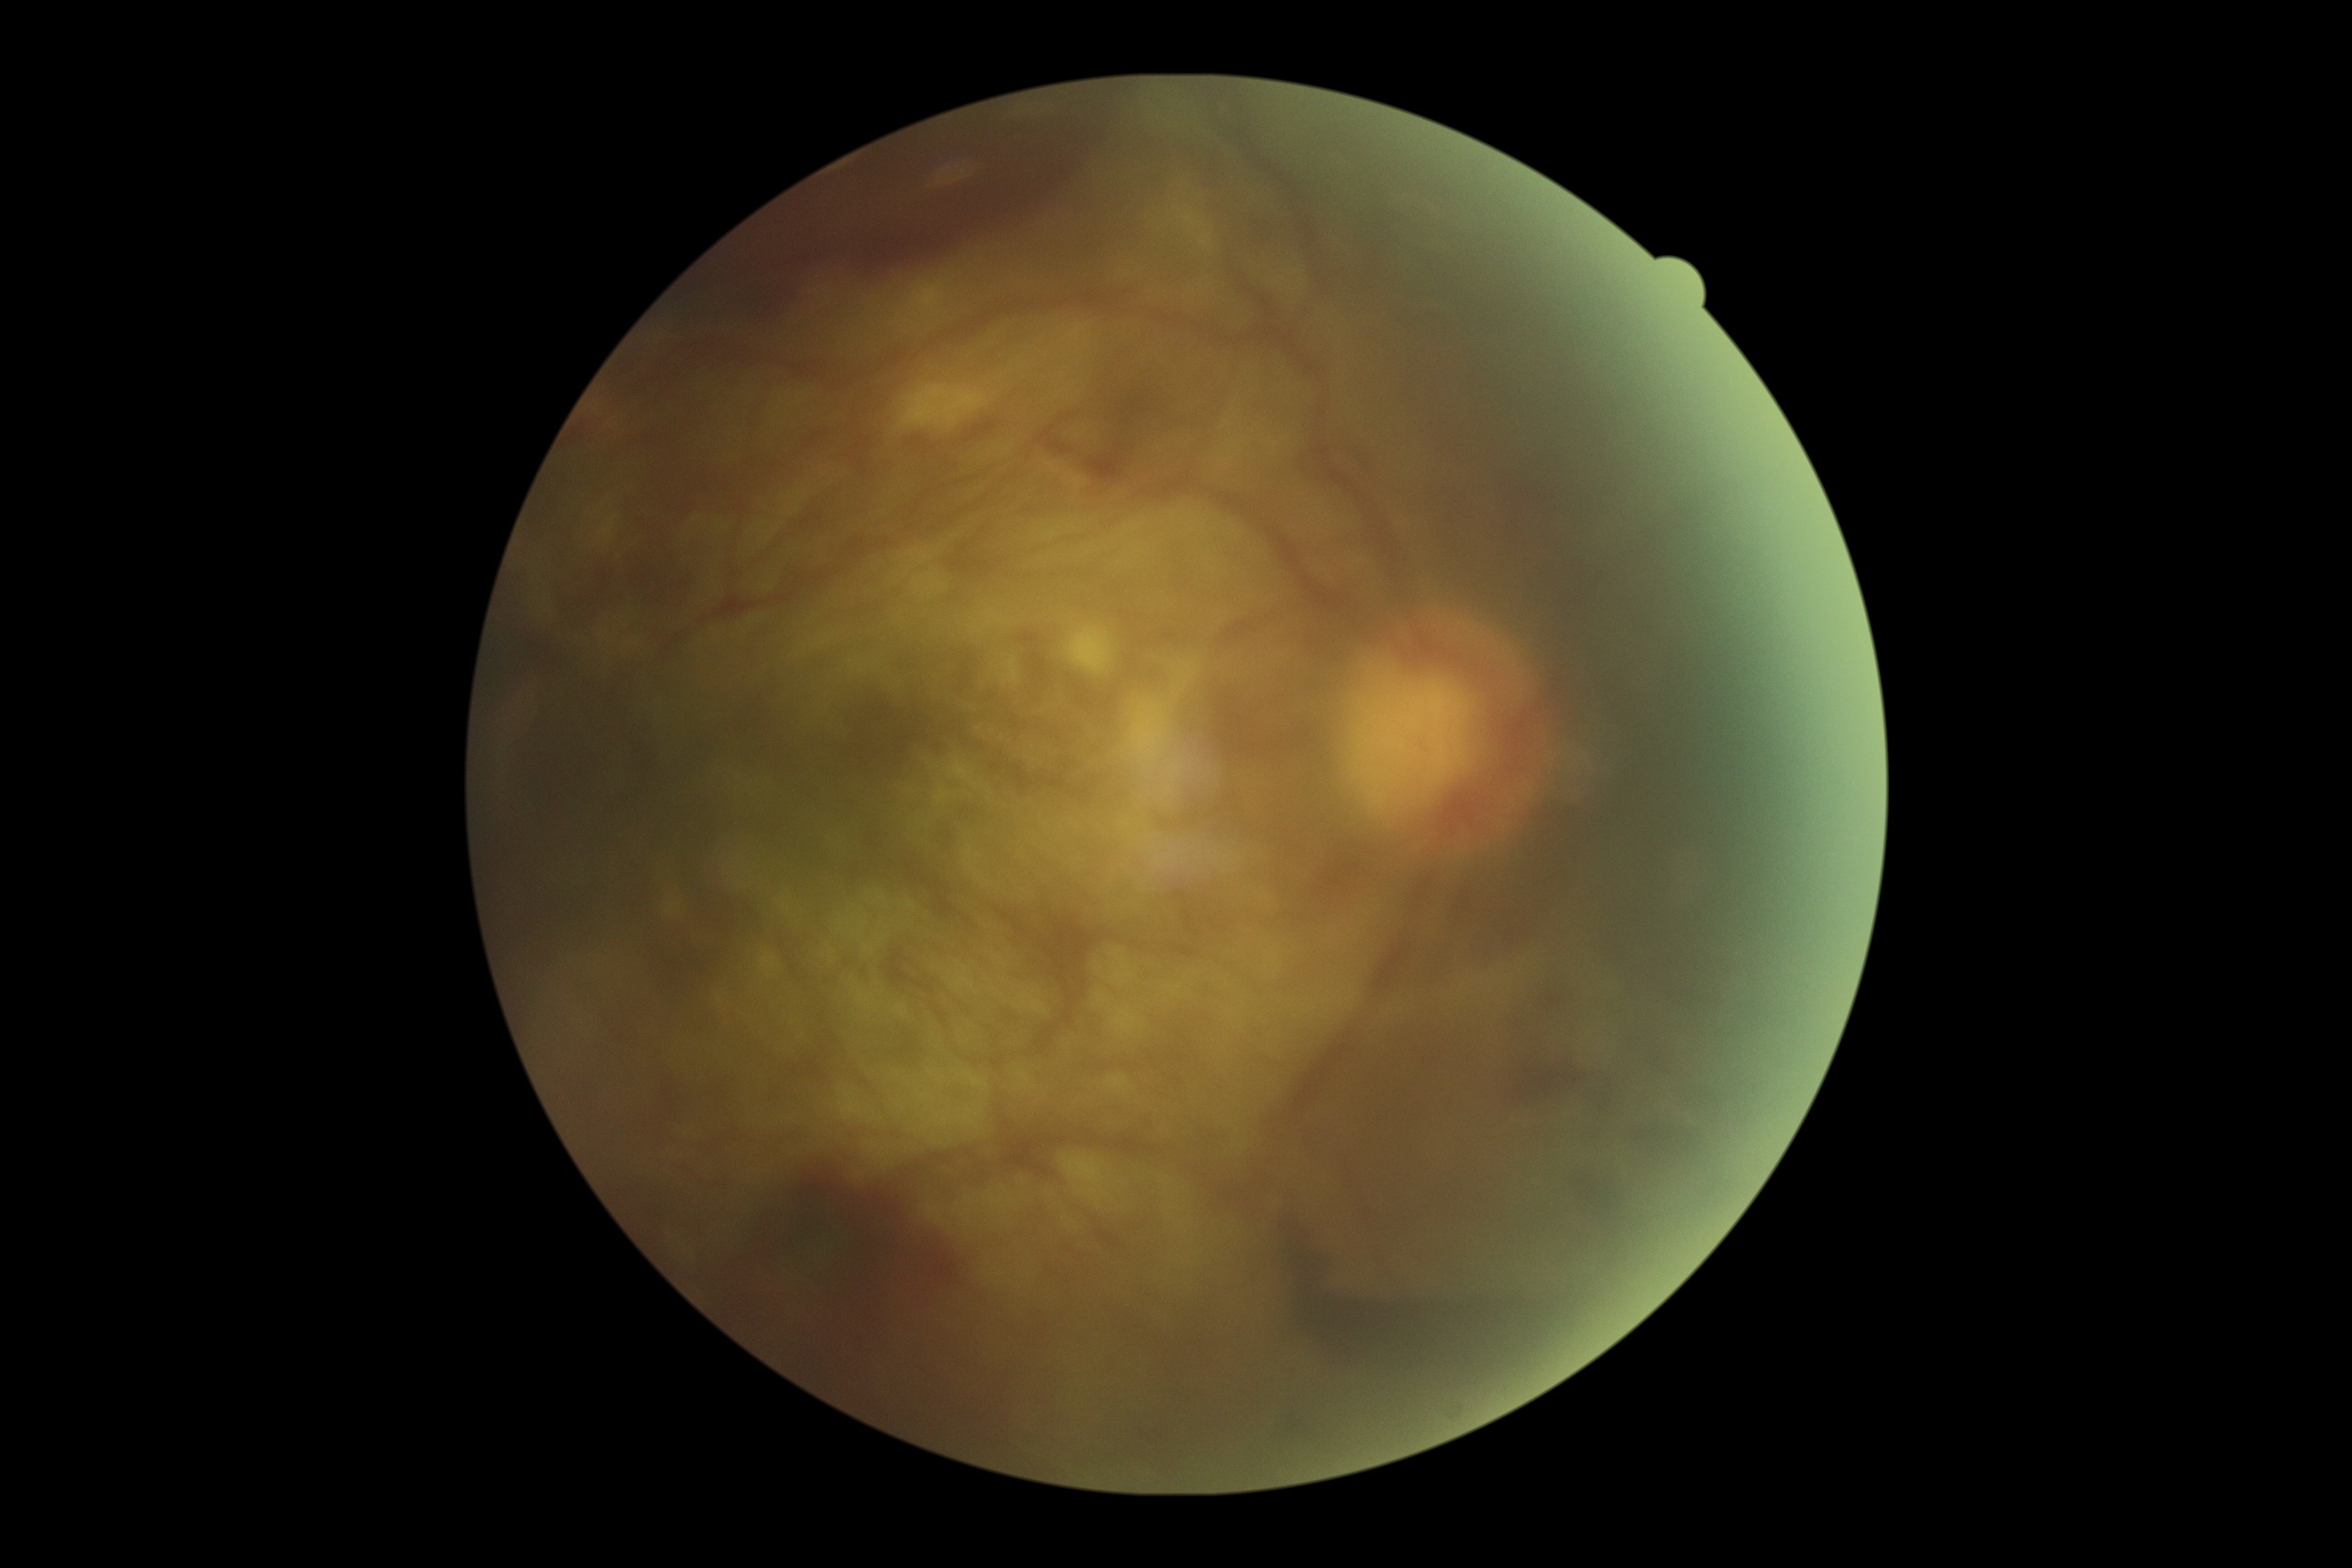
DR grade: 4/4.